Infant wide-field fundus photograph · image size 1440x1080 · camera: Natus RetCam Envision (130° FOV)
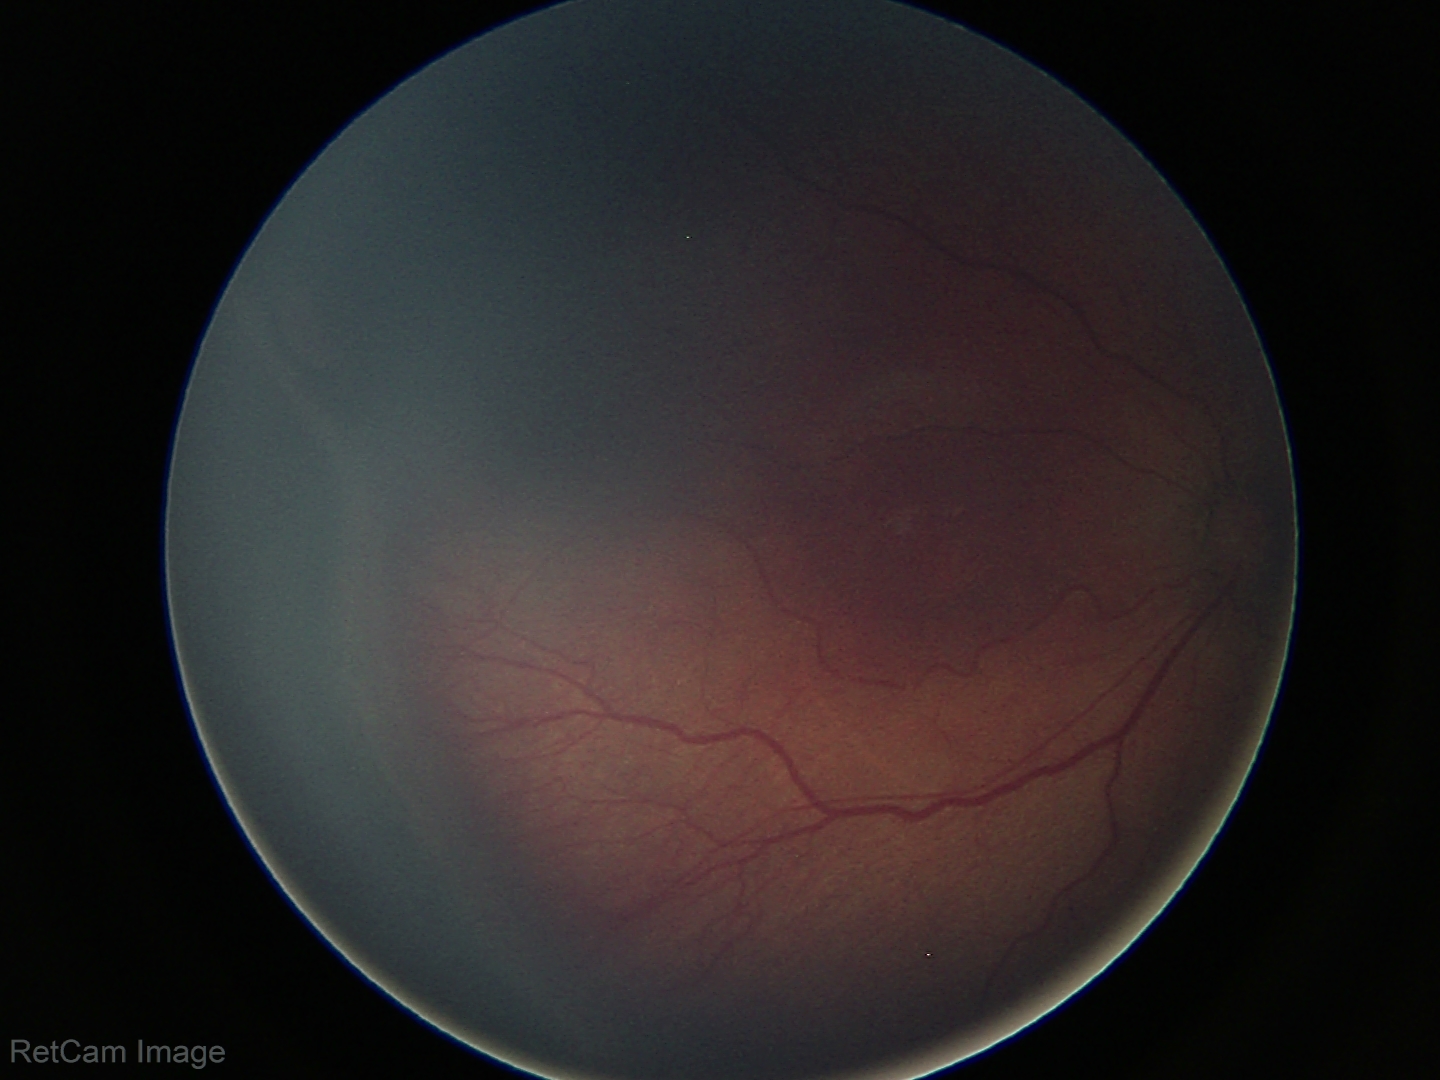

Series diagnosed as ROP stage 3.